Tabletop color fundus camera image:
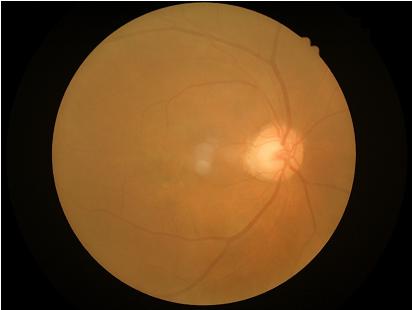
Quality assessment:
- overall: poor, ungradable
- clarity: noticeable blur in the optic disc, vessels, or background
- contrast: poor dynamic range
- illumination: good illumination and color balance